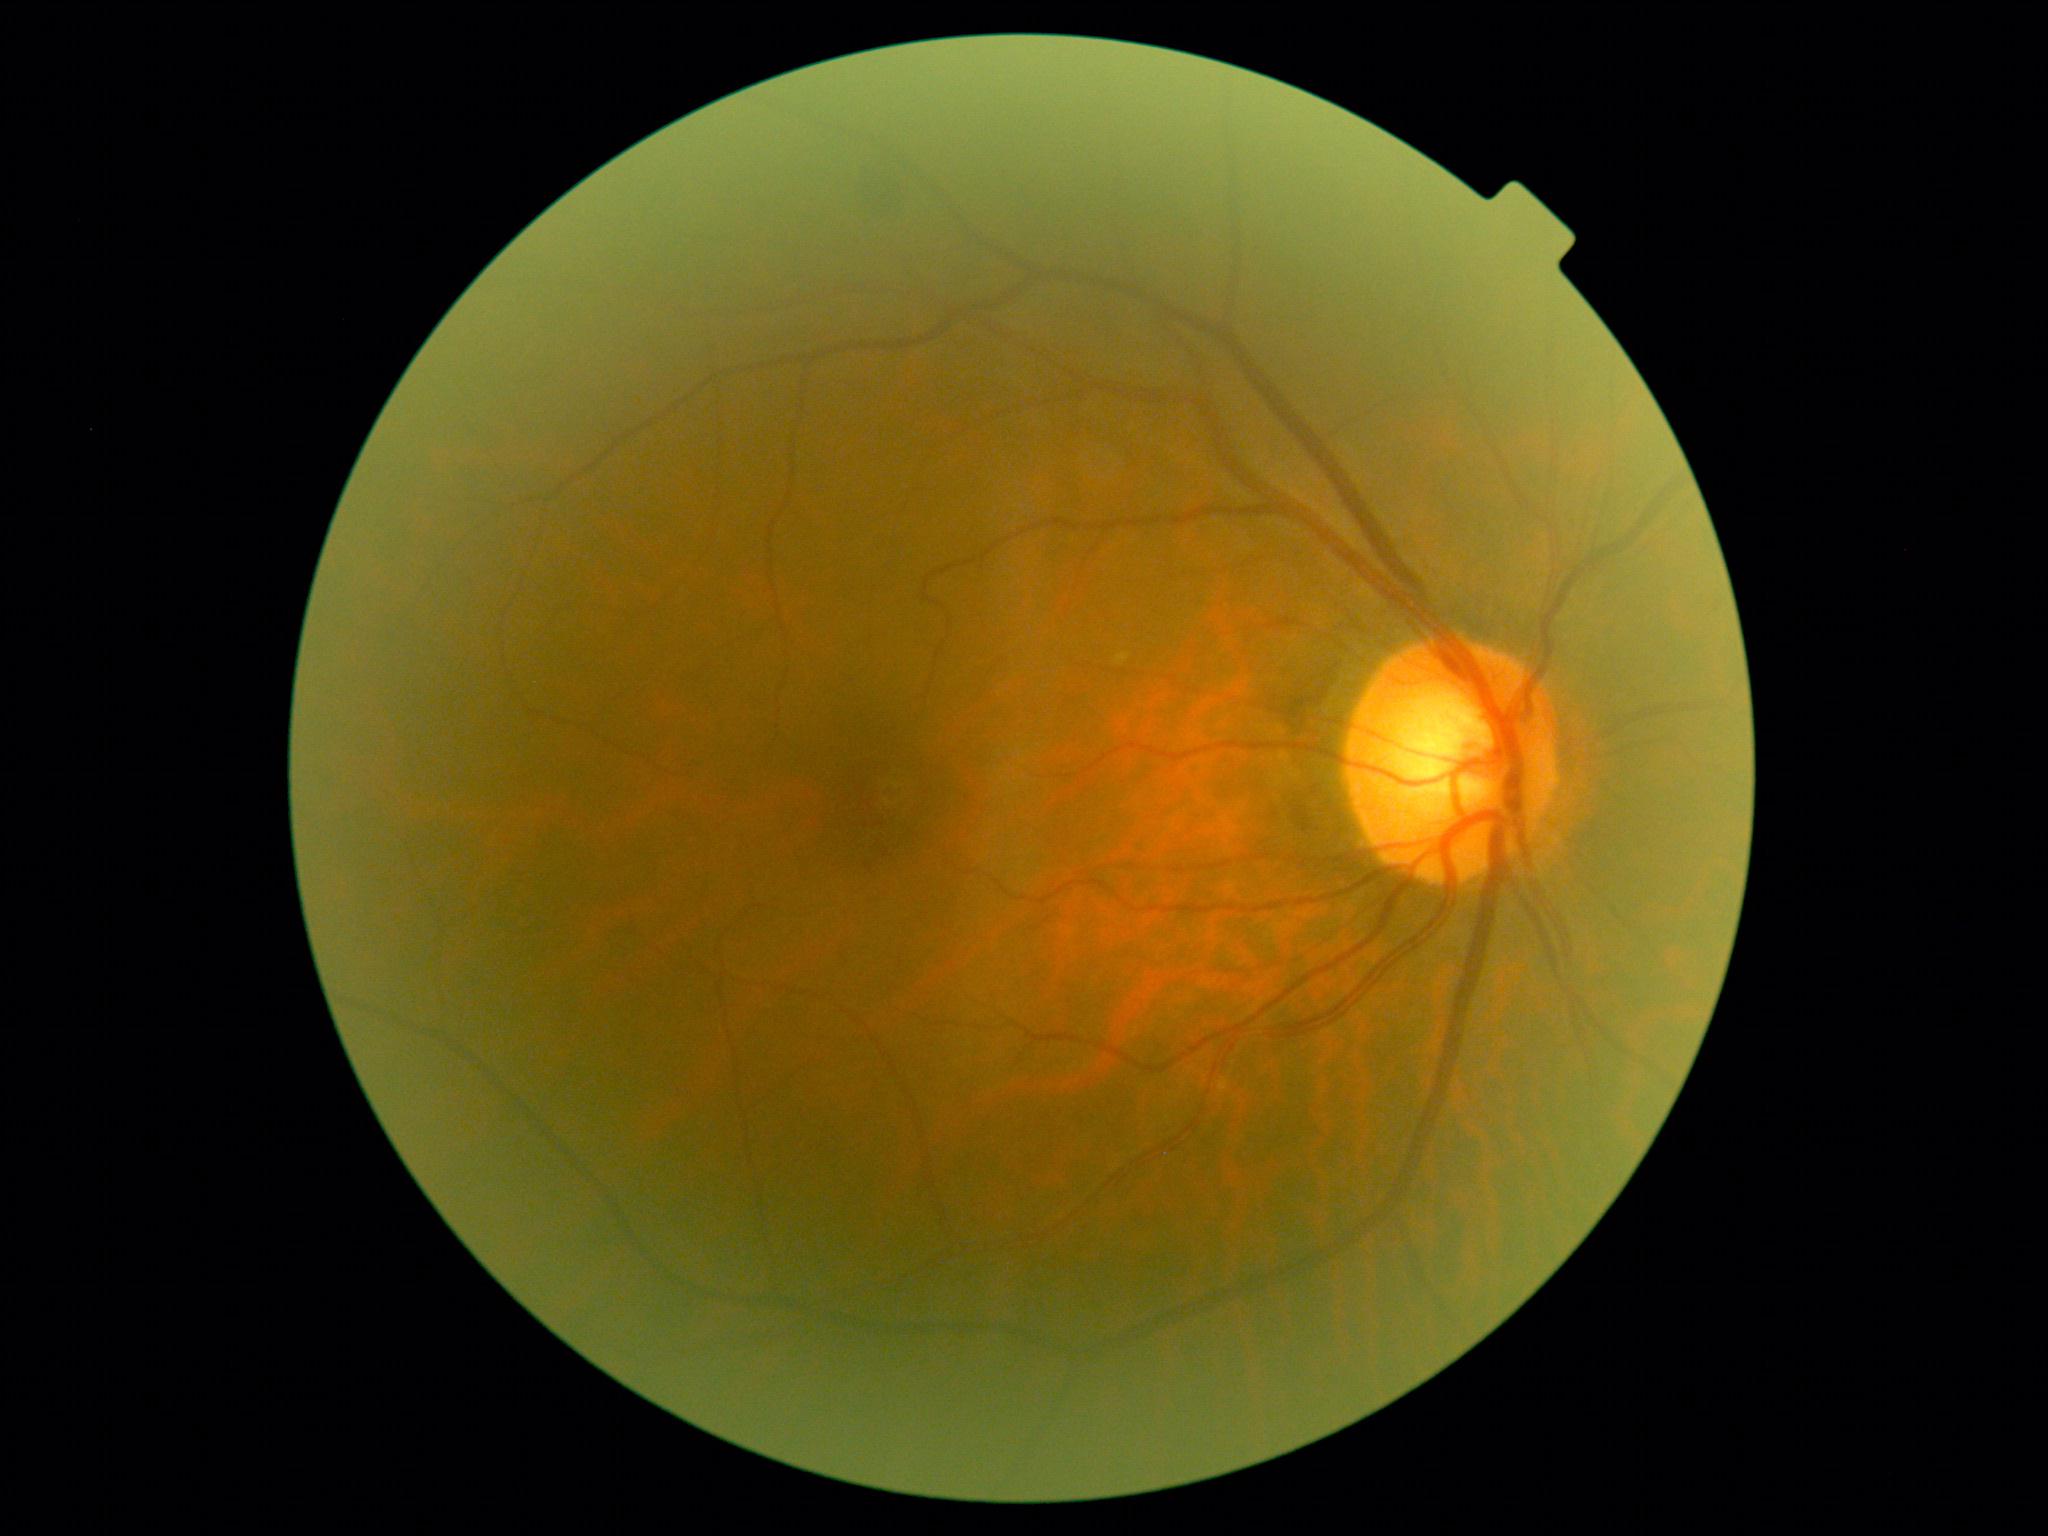

{"dr_grade": "2/4"}